Wide-field fundus photograph from neonatal ROP screening:
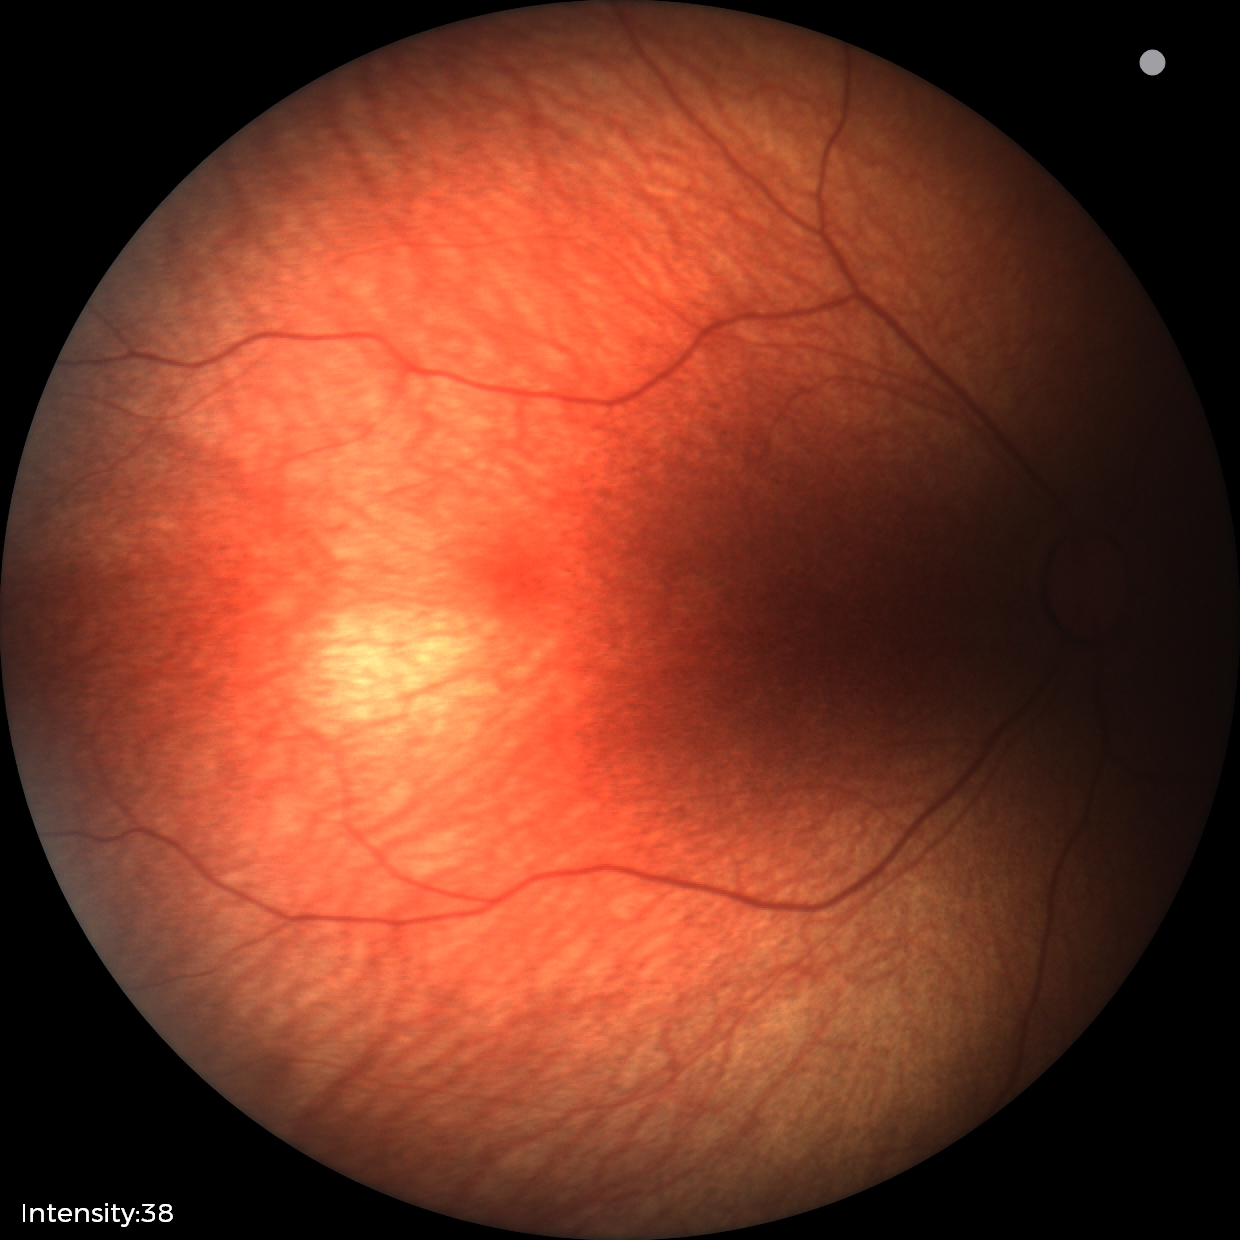
Impression: physiological appearance.